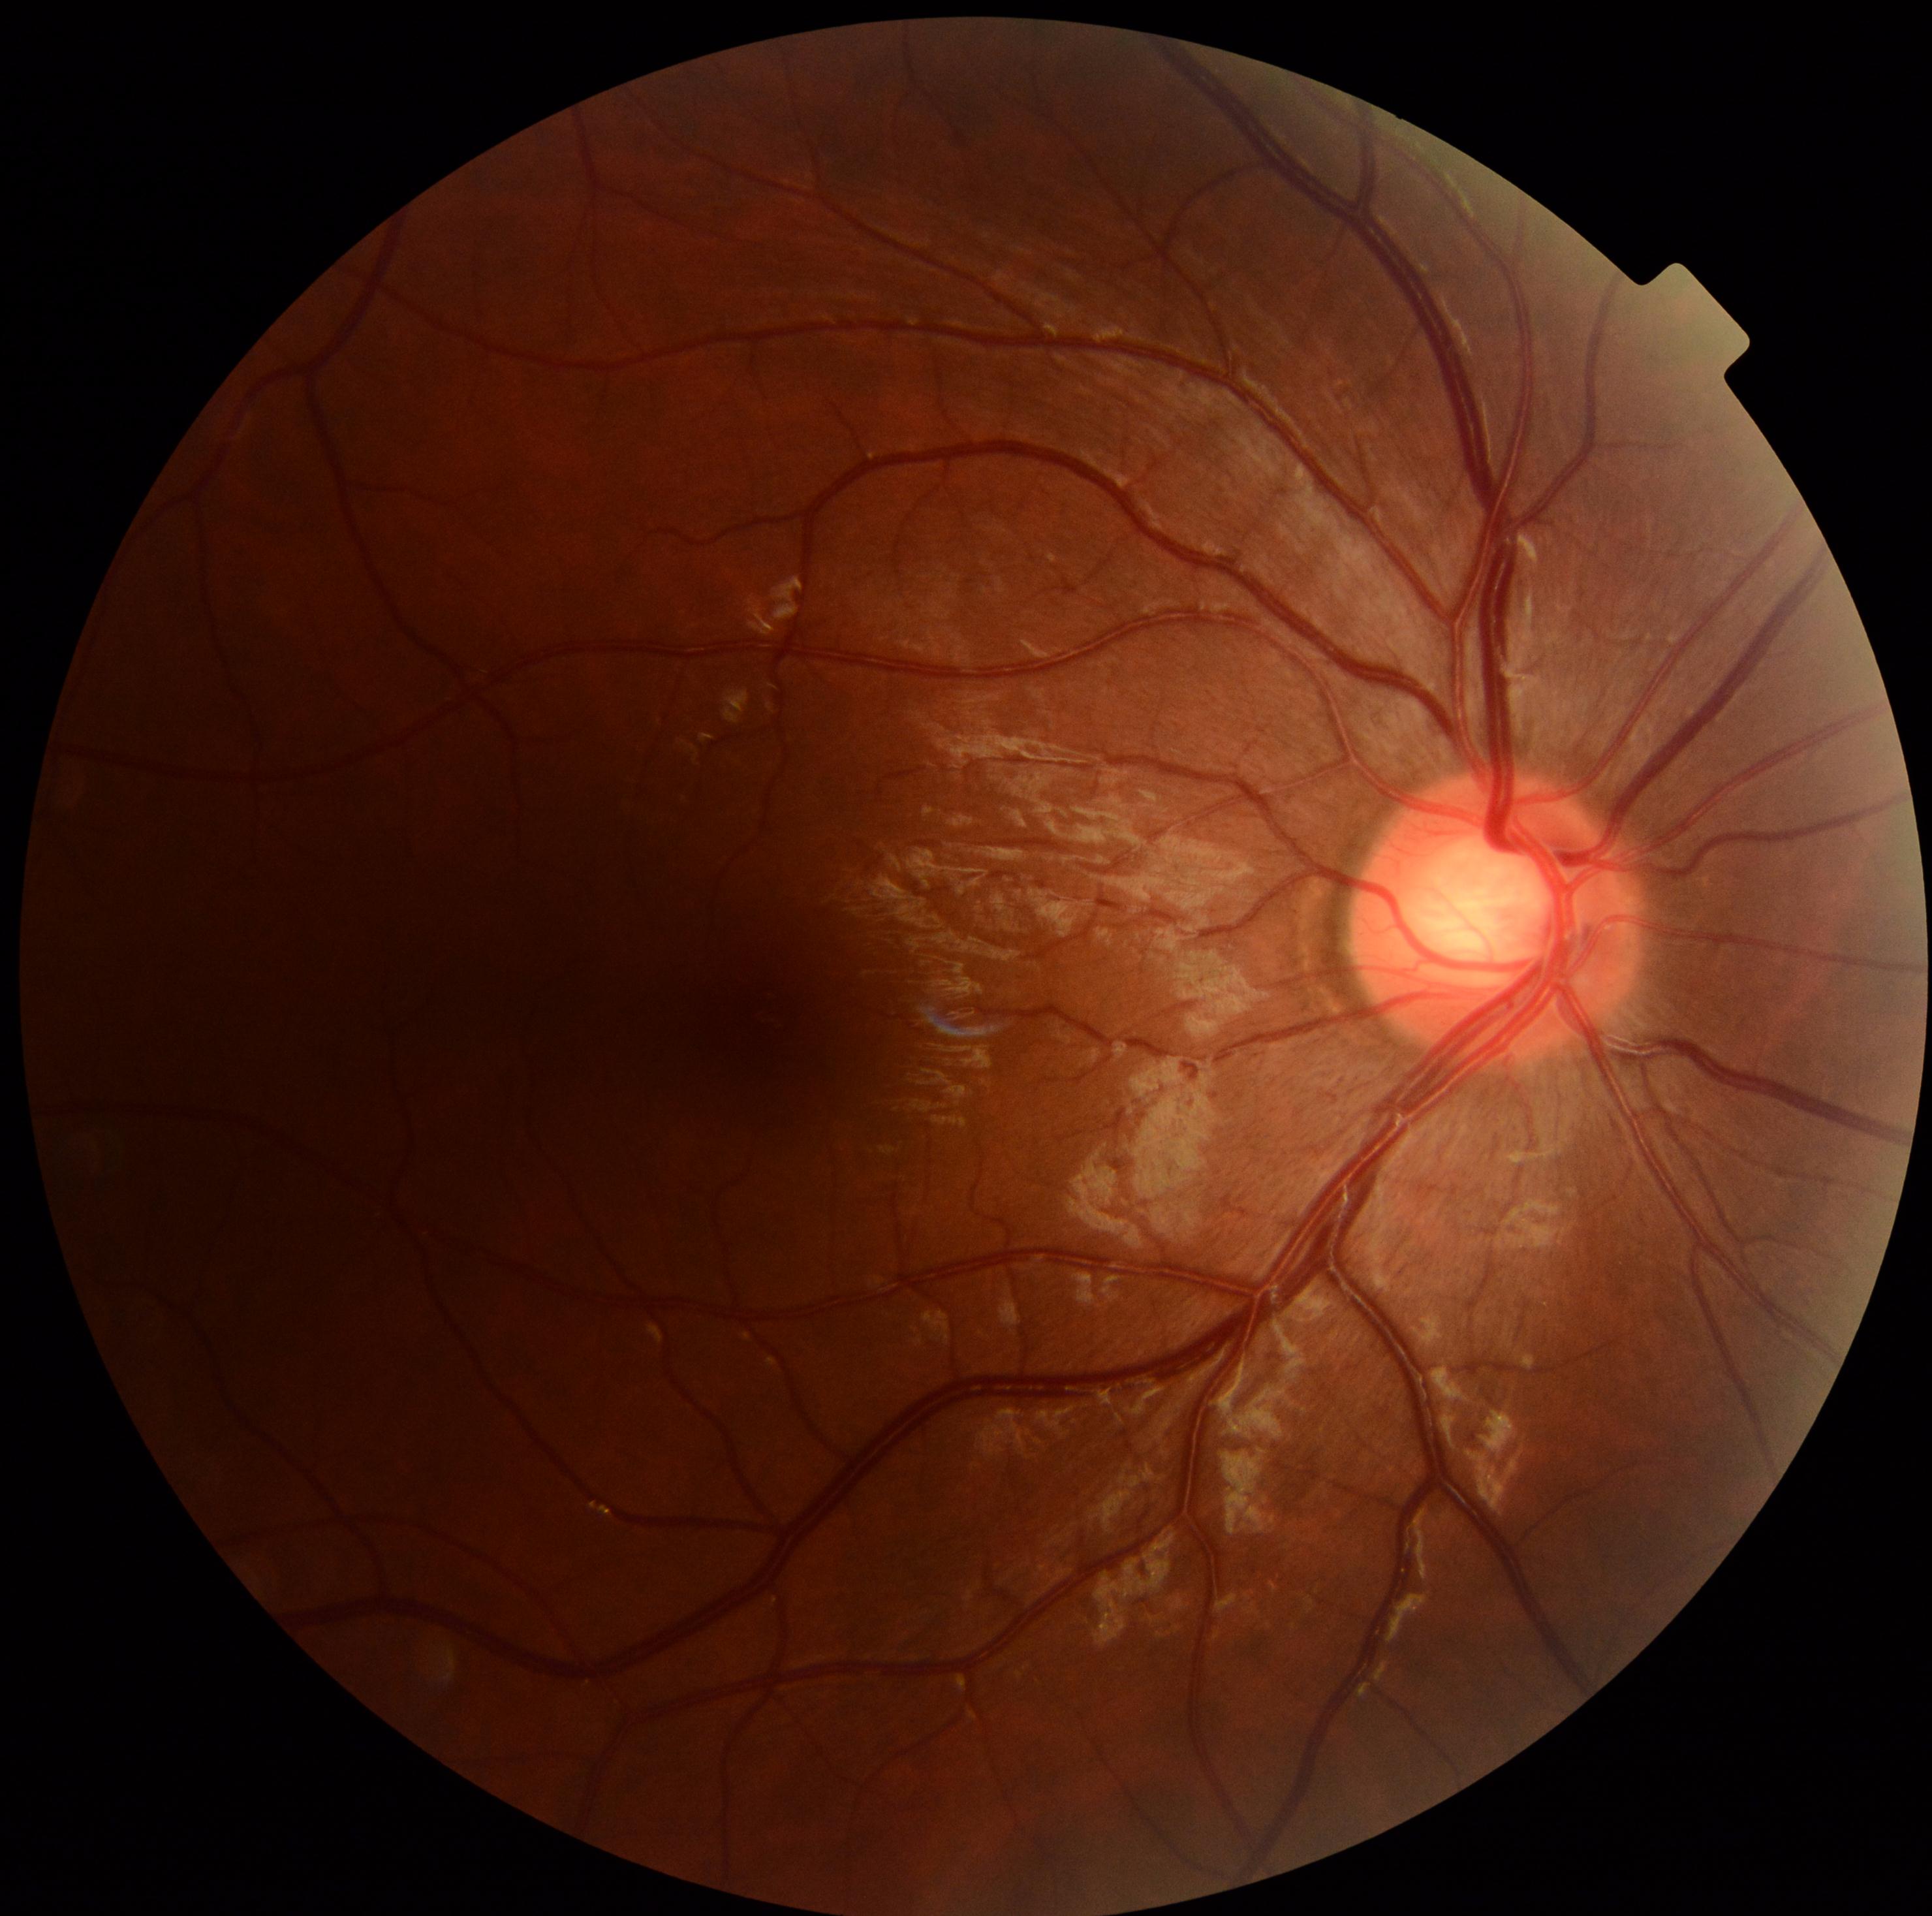 No DR findings.
DR: grade 0.